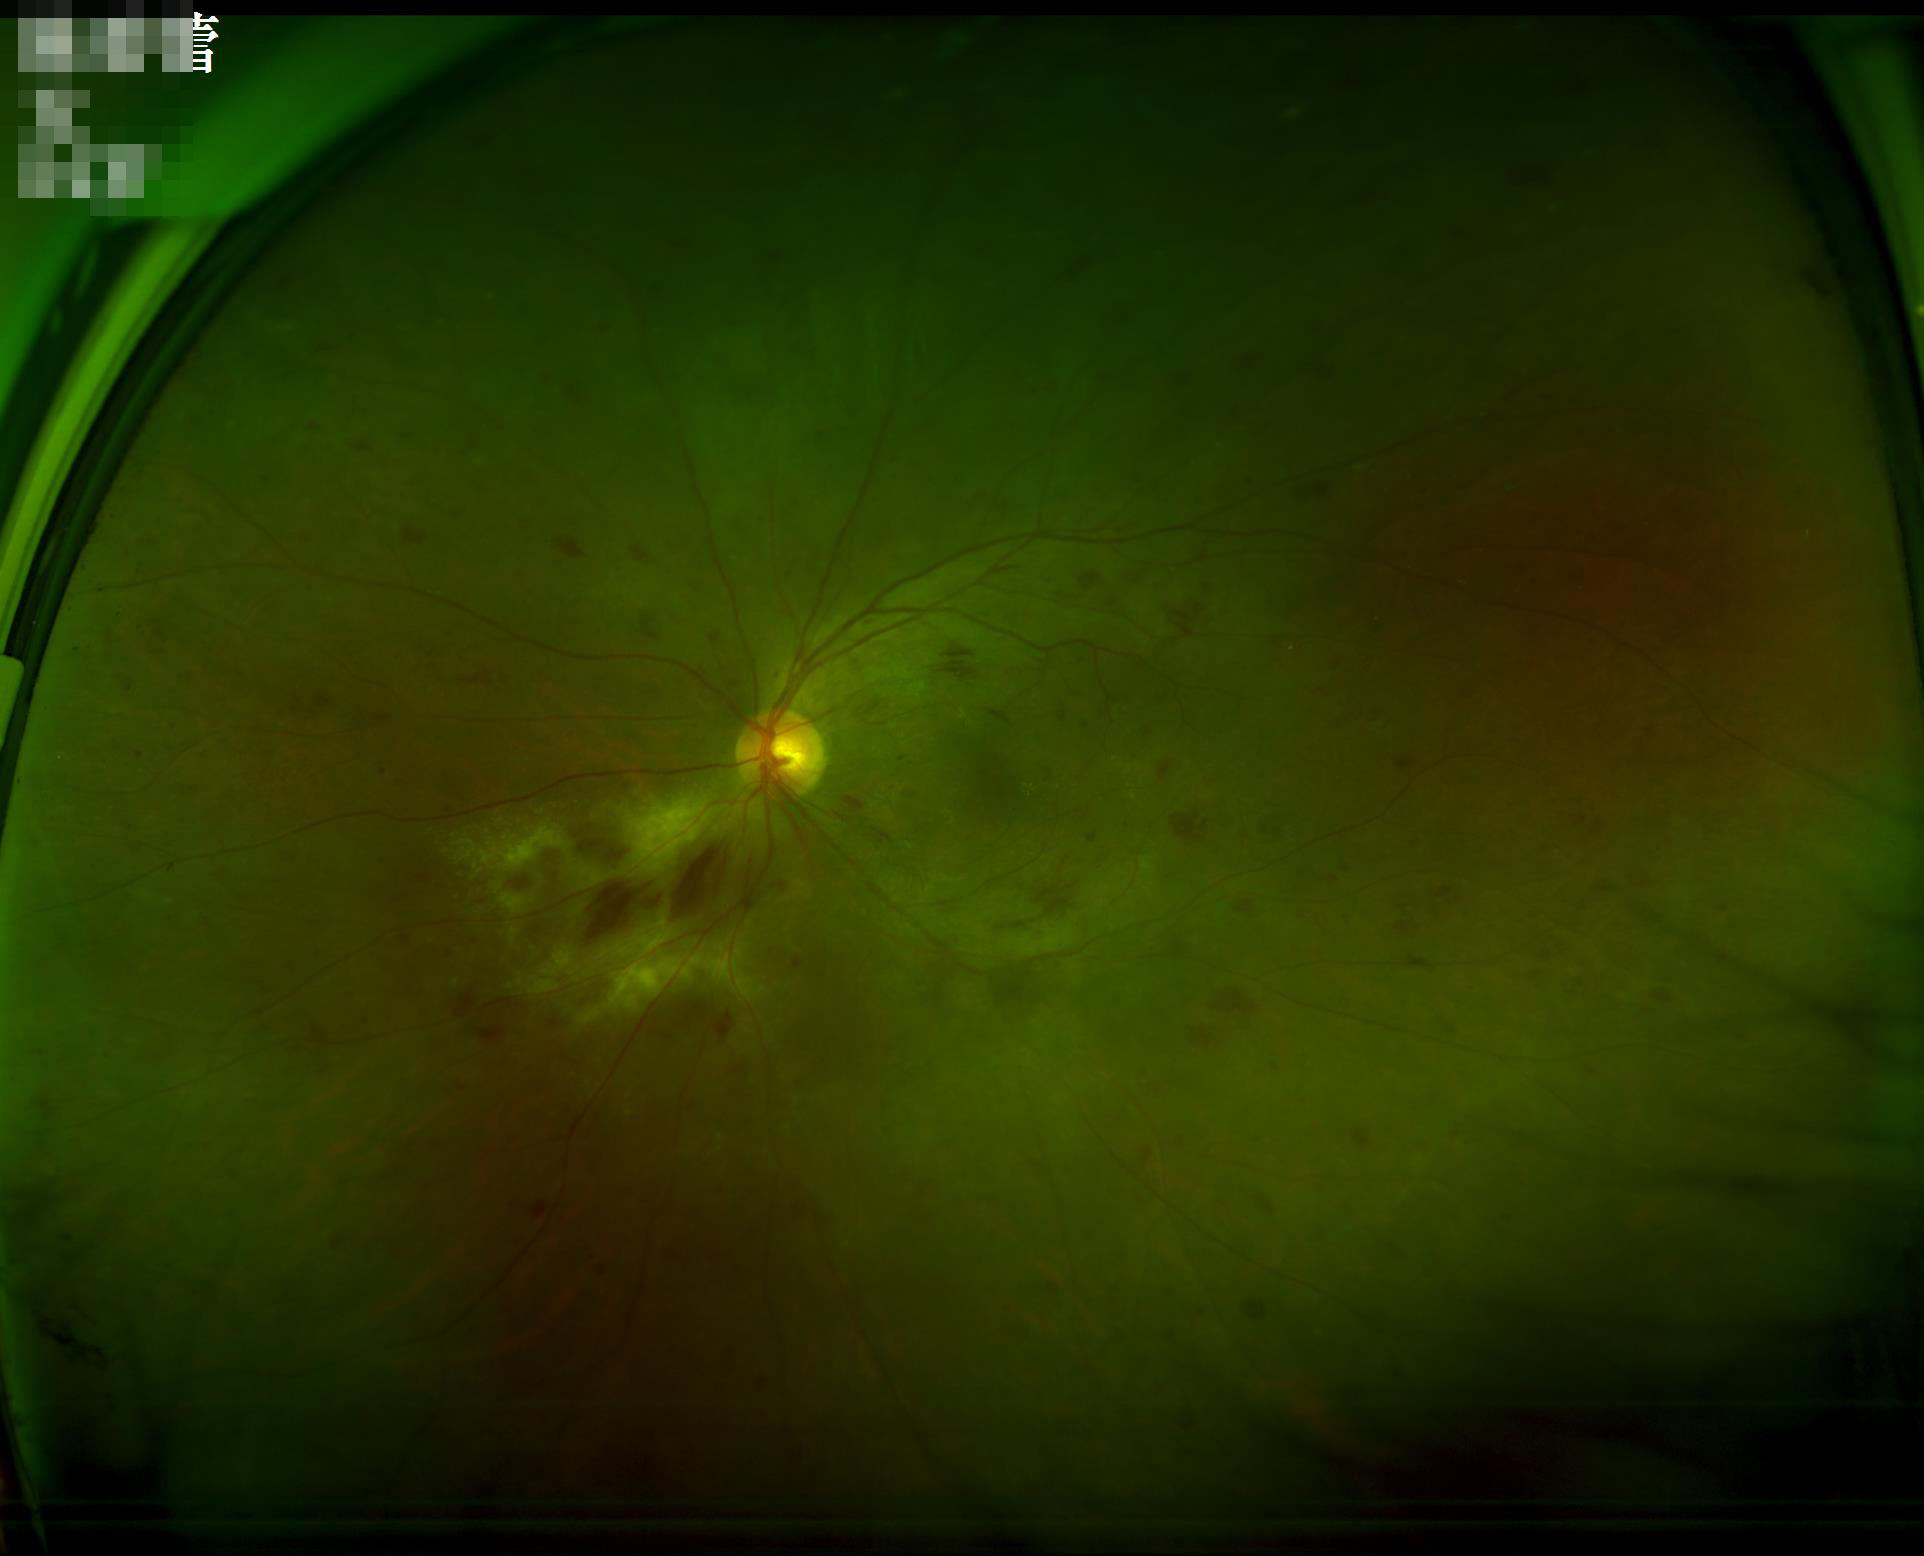

The image is clear.
Adequate contrast for distinguishing structures.
Acceptable image quality.
Even illumination with no color cast.